Ultra-widefield fundus mosaic — 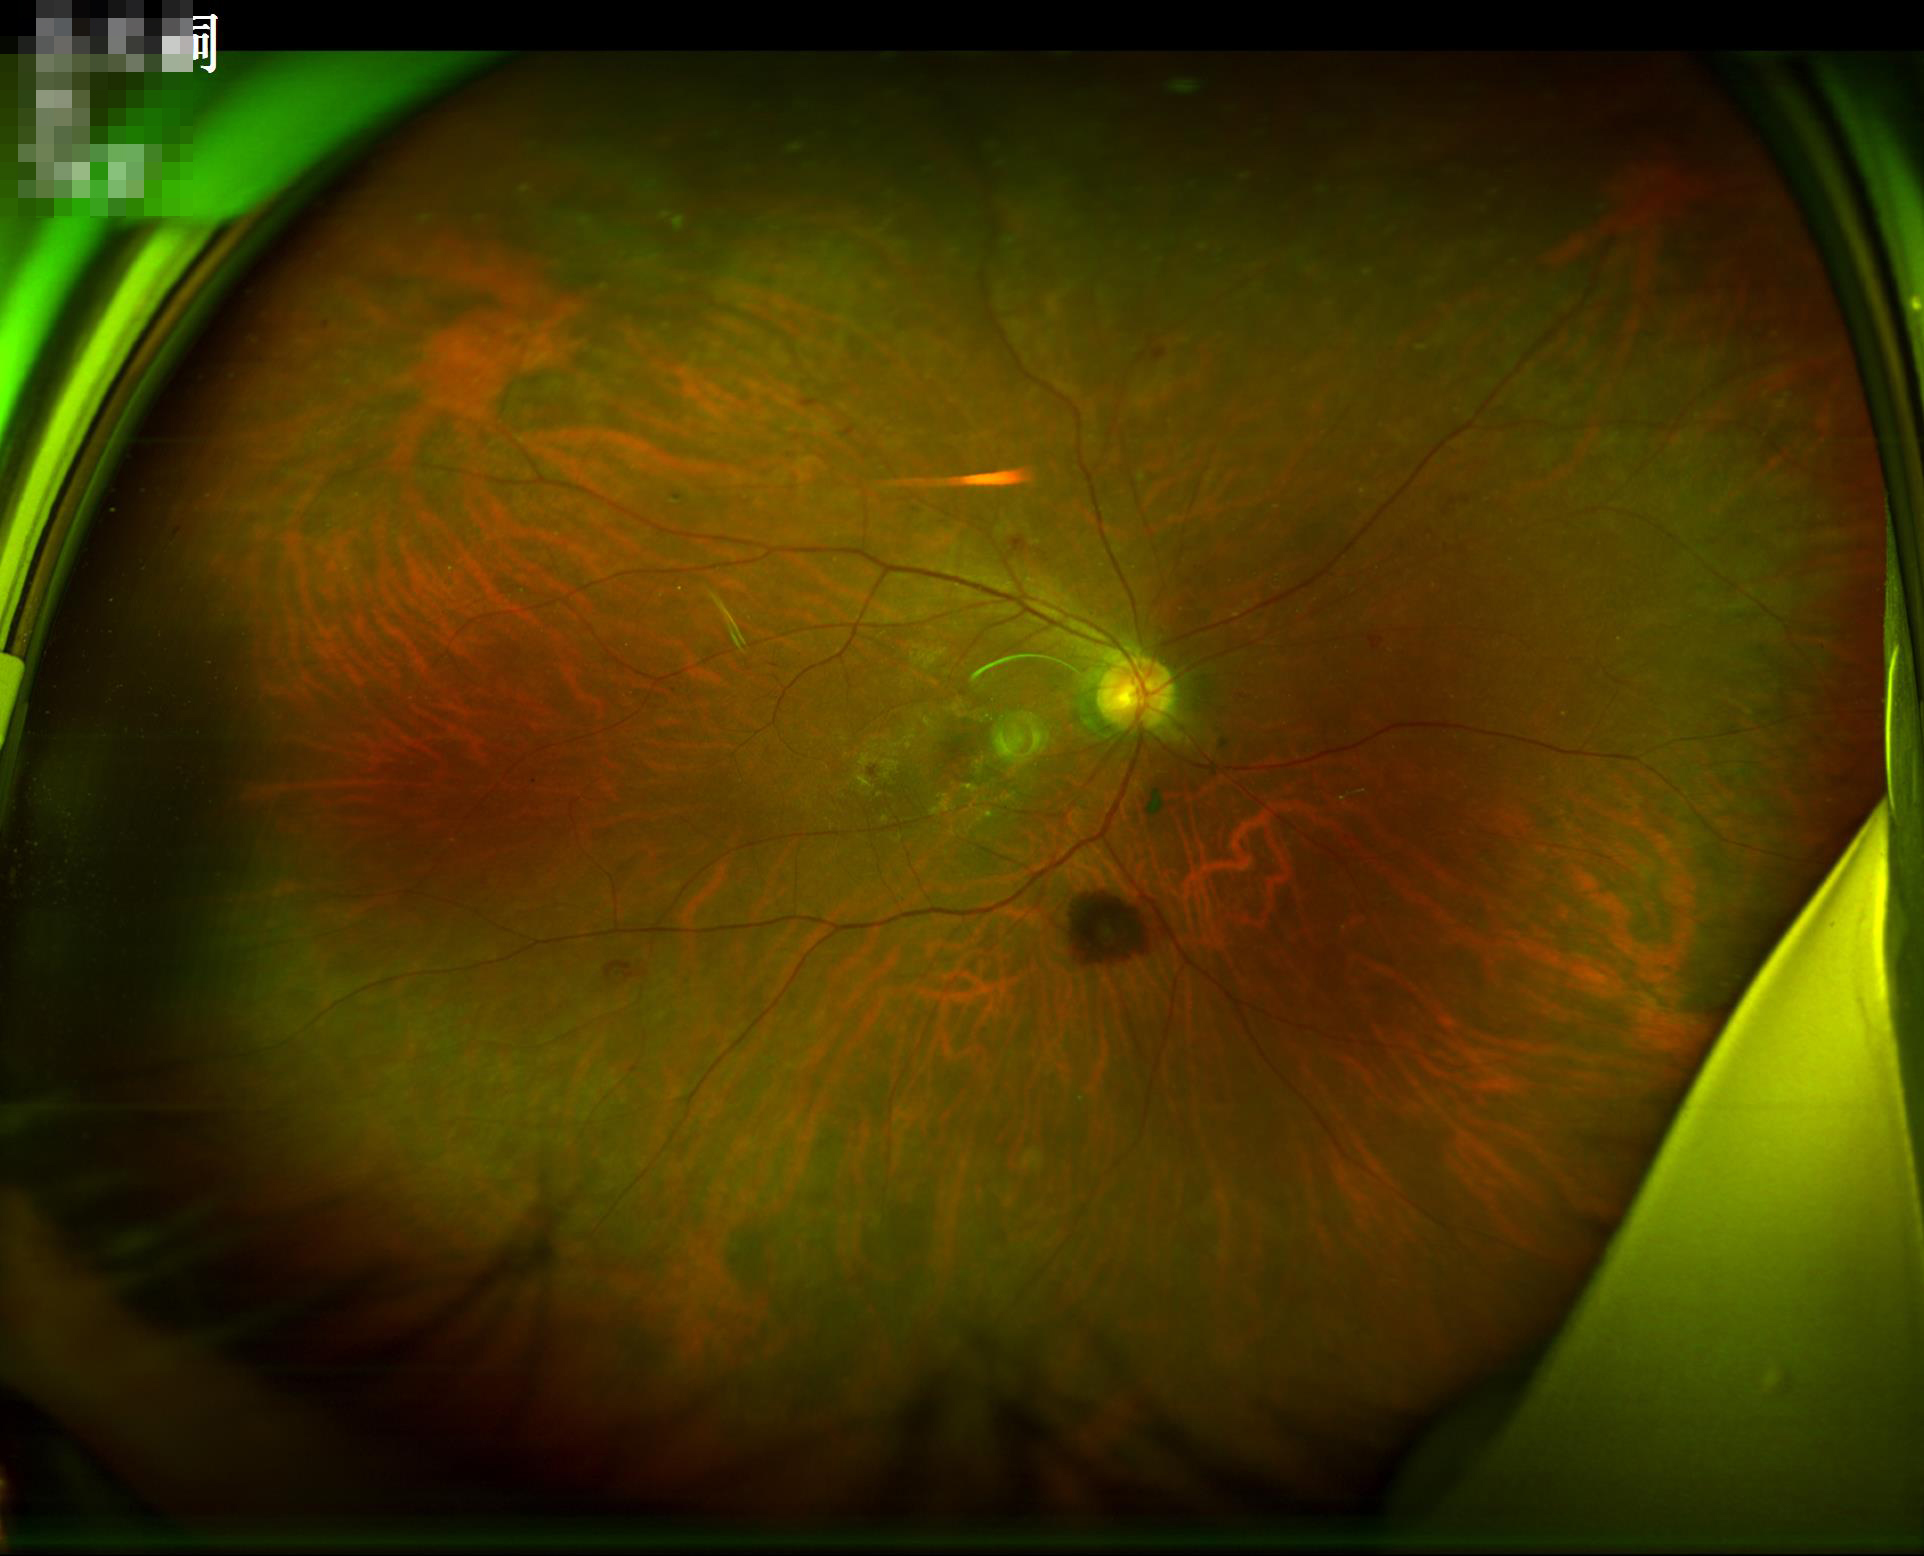
{
  "illumination": "adequate",
  "overall_quality": "satisfactory",
  "contrast": "satisfactory"
}